Fundus photo · optic disc region crop · camera: Nidek AFC-330 — 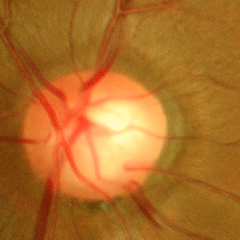
The image shows advanced-stage glaucoma.